NIDEK AFC-230 fundus camera, FOV: 45 degrees, nonmydriatic fundus photograph, 848 by 848 pixels
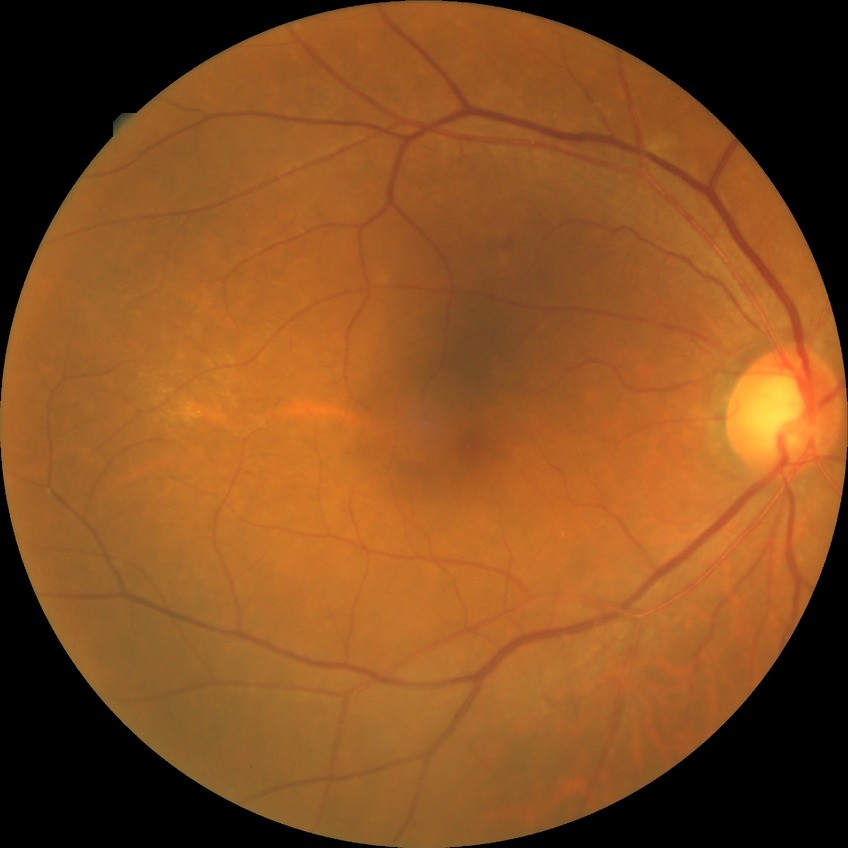 Davis stage: NDR.